Wide-field fundus photograph of an infant.
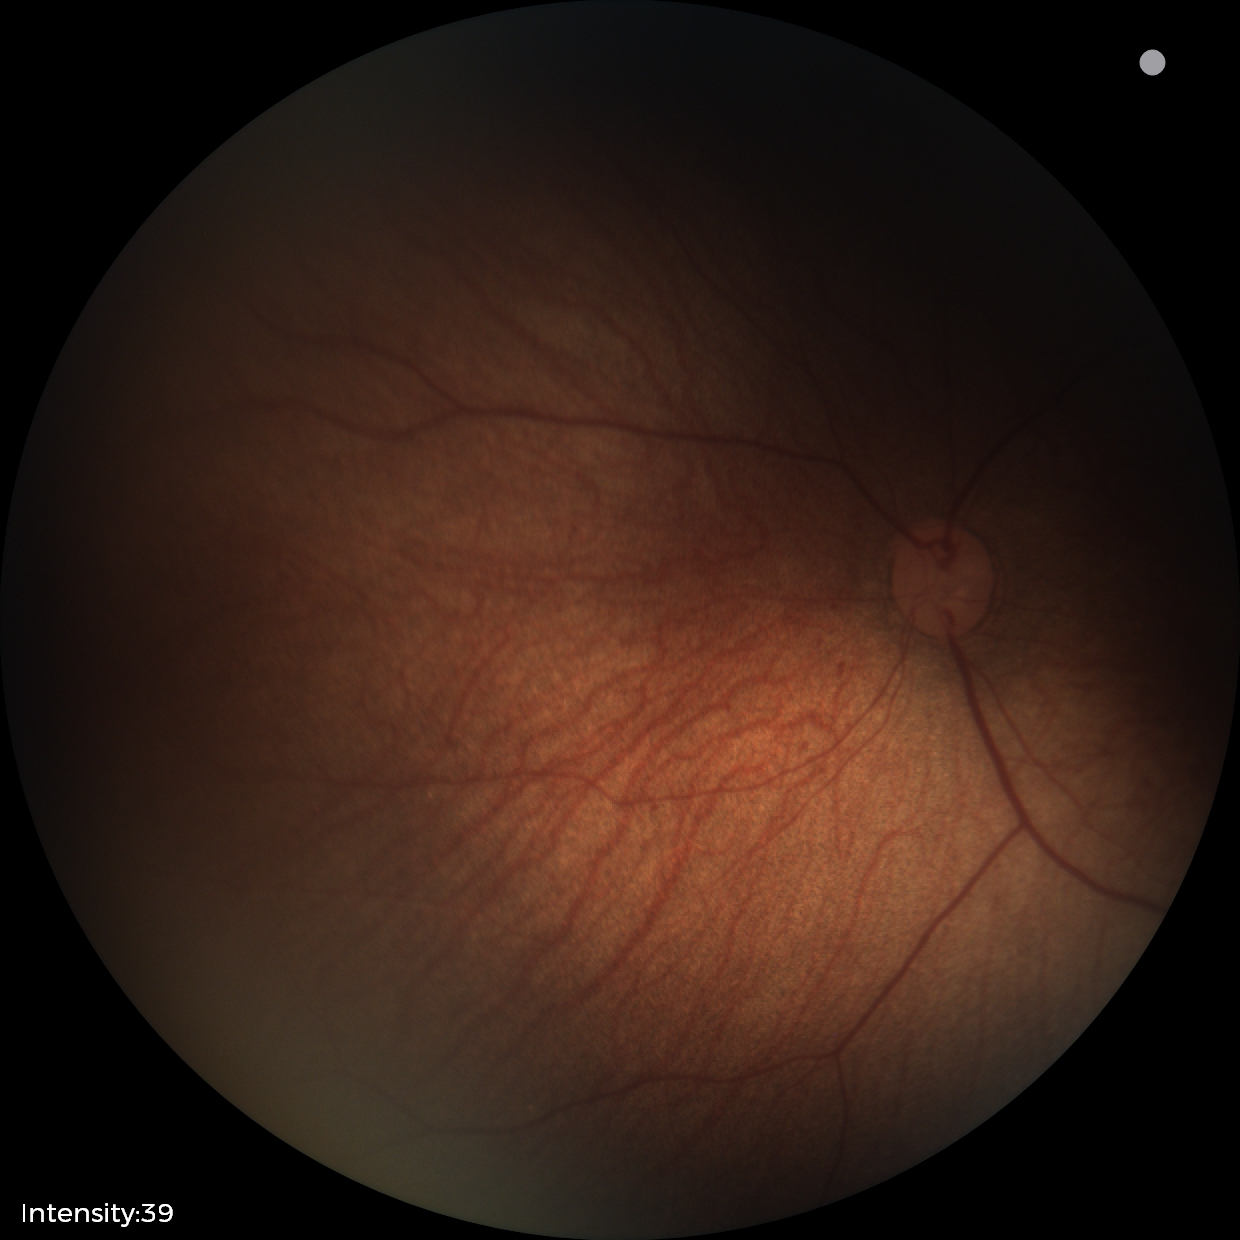

Physiological retinal appearance for postconceptual age.